2212x1672px. CFP:
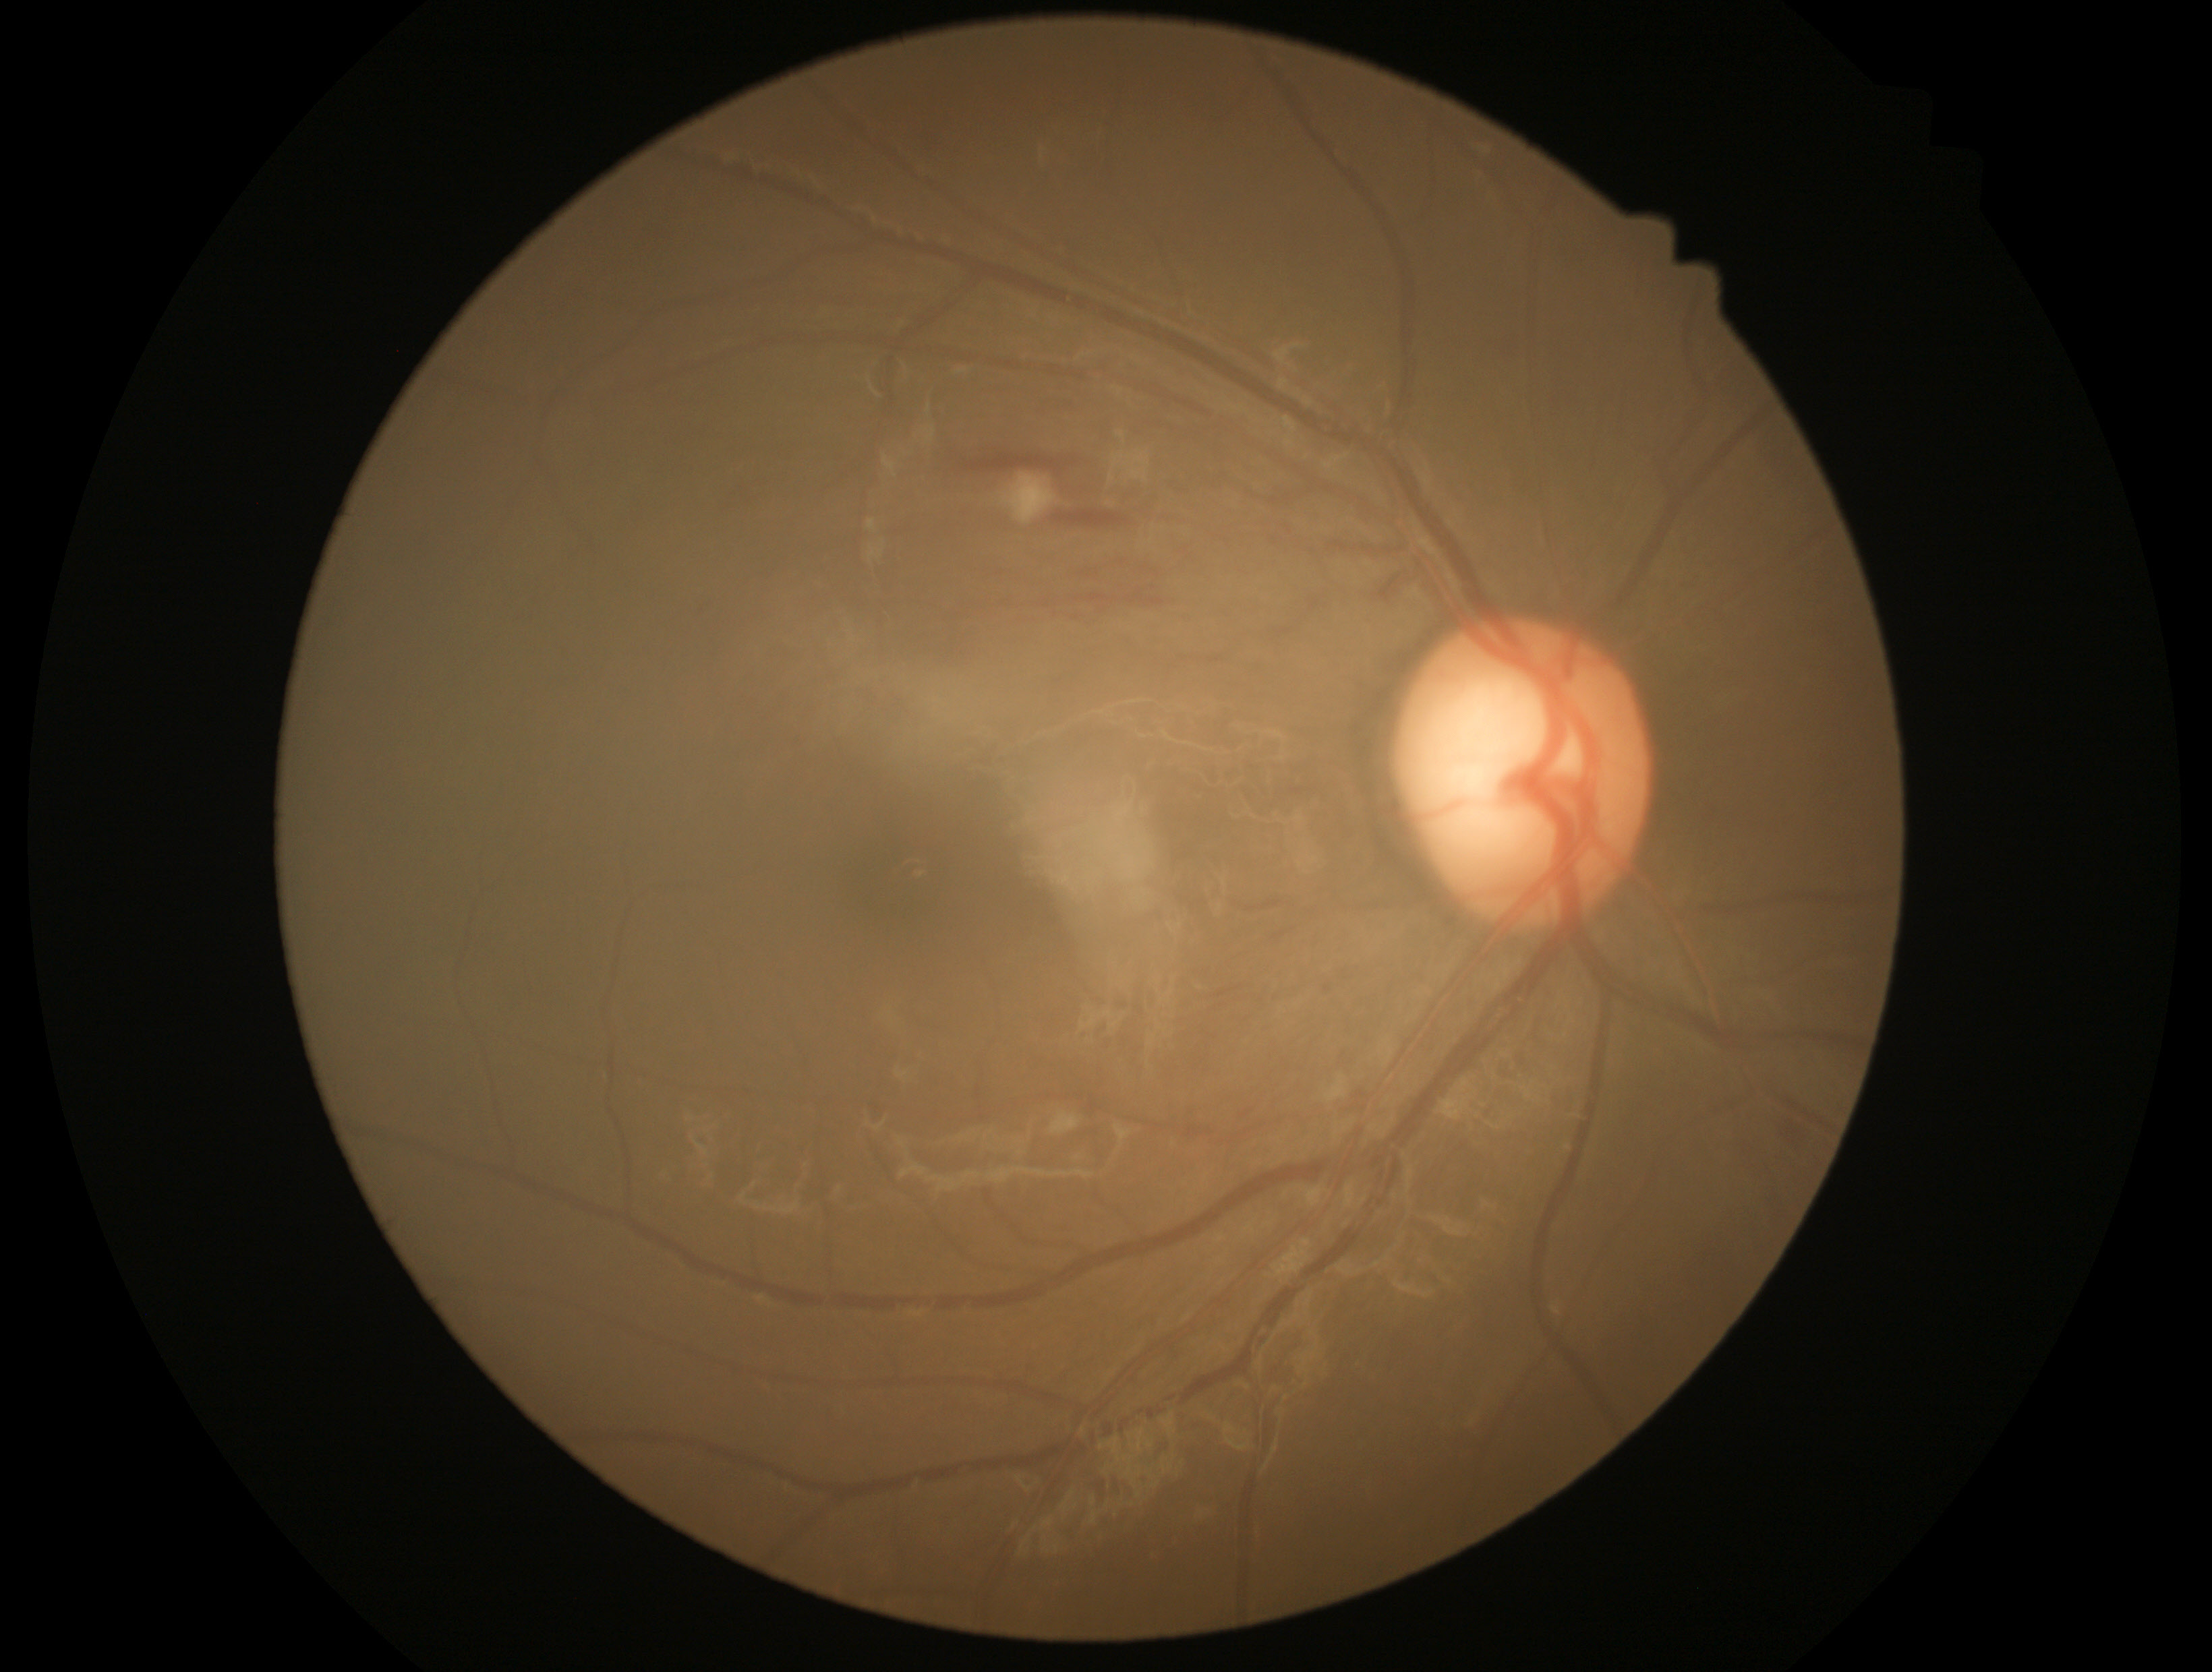
- DR severity — moderate NPDR (grade 2)